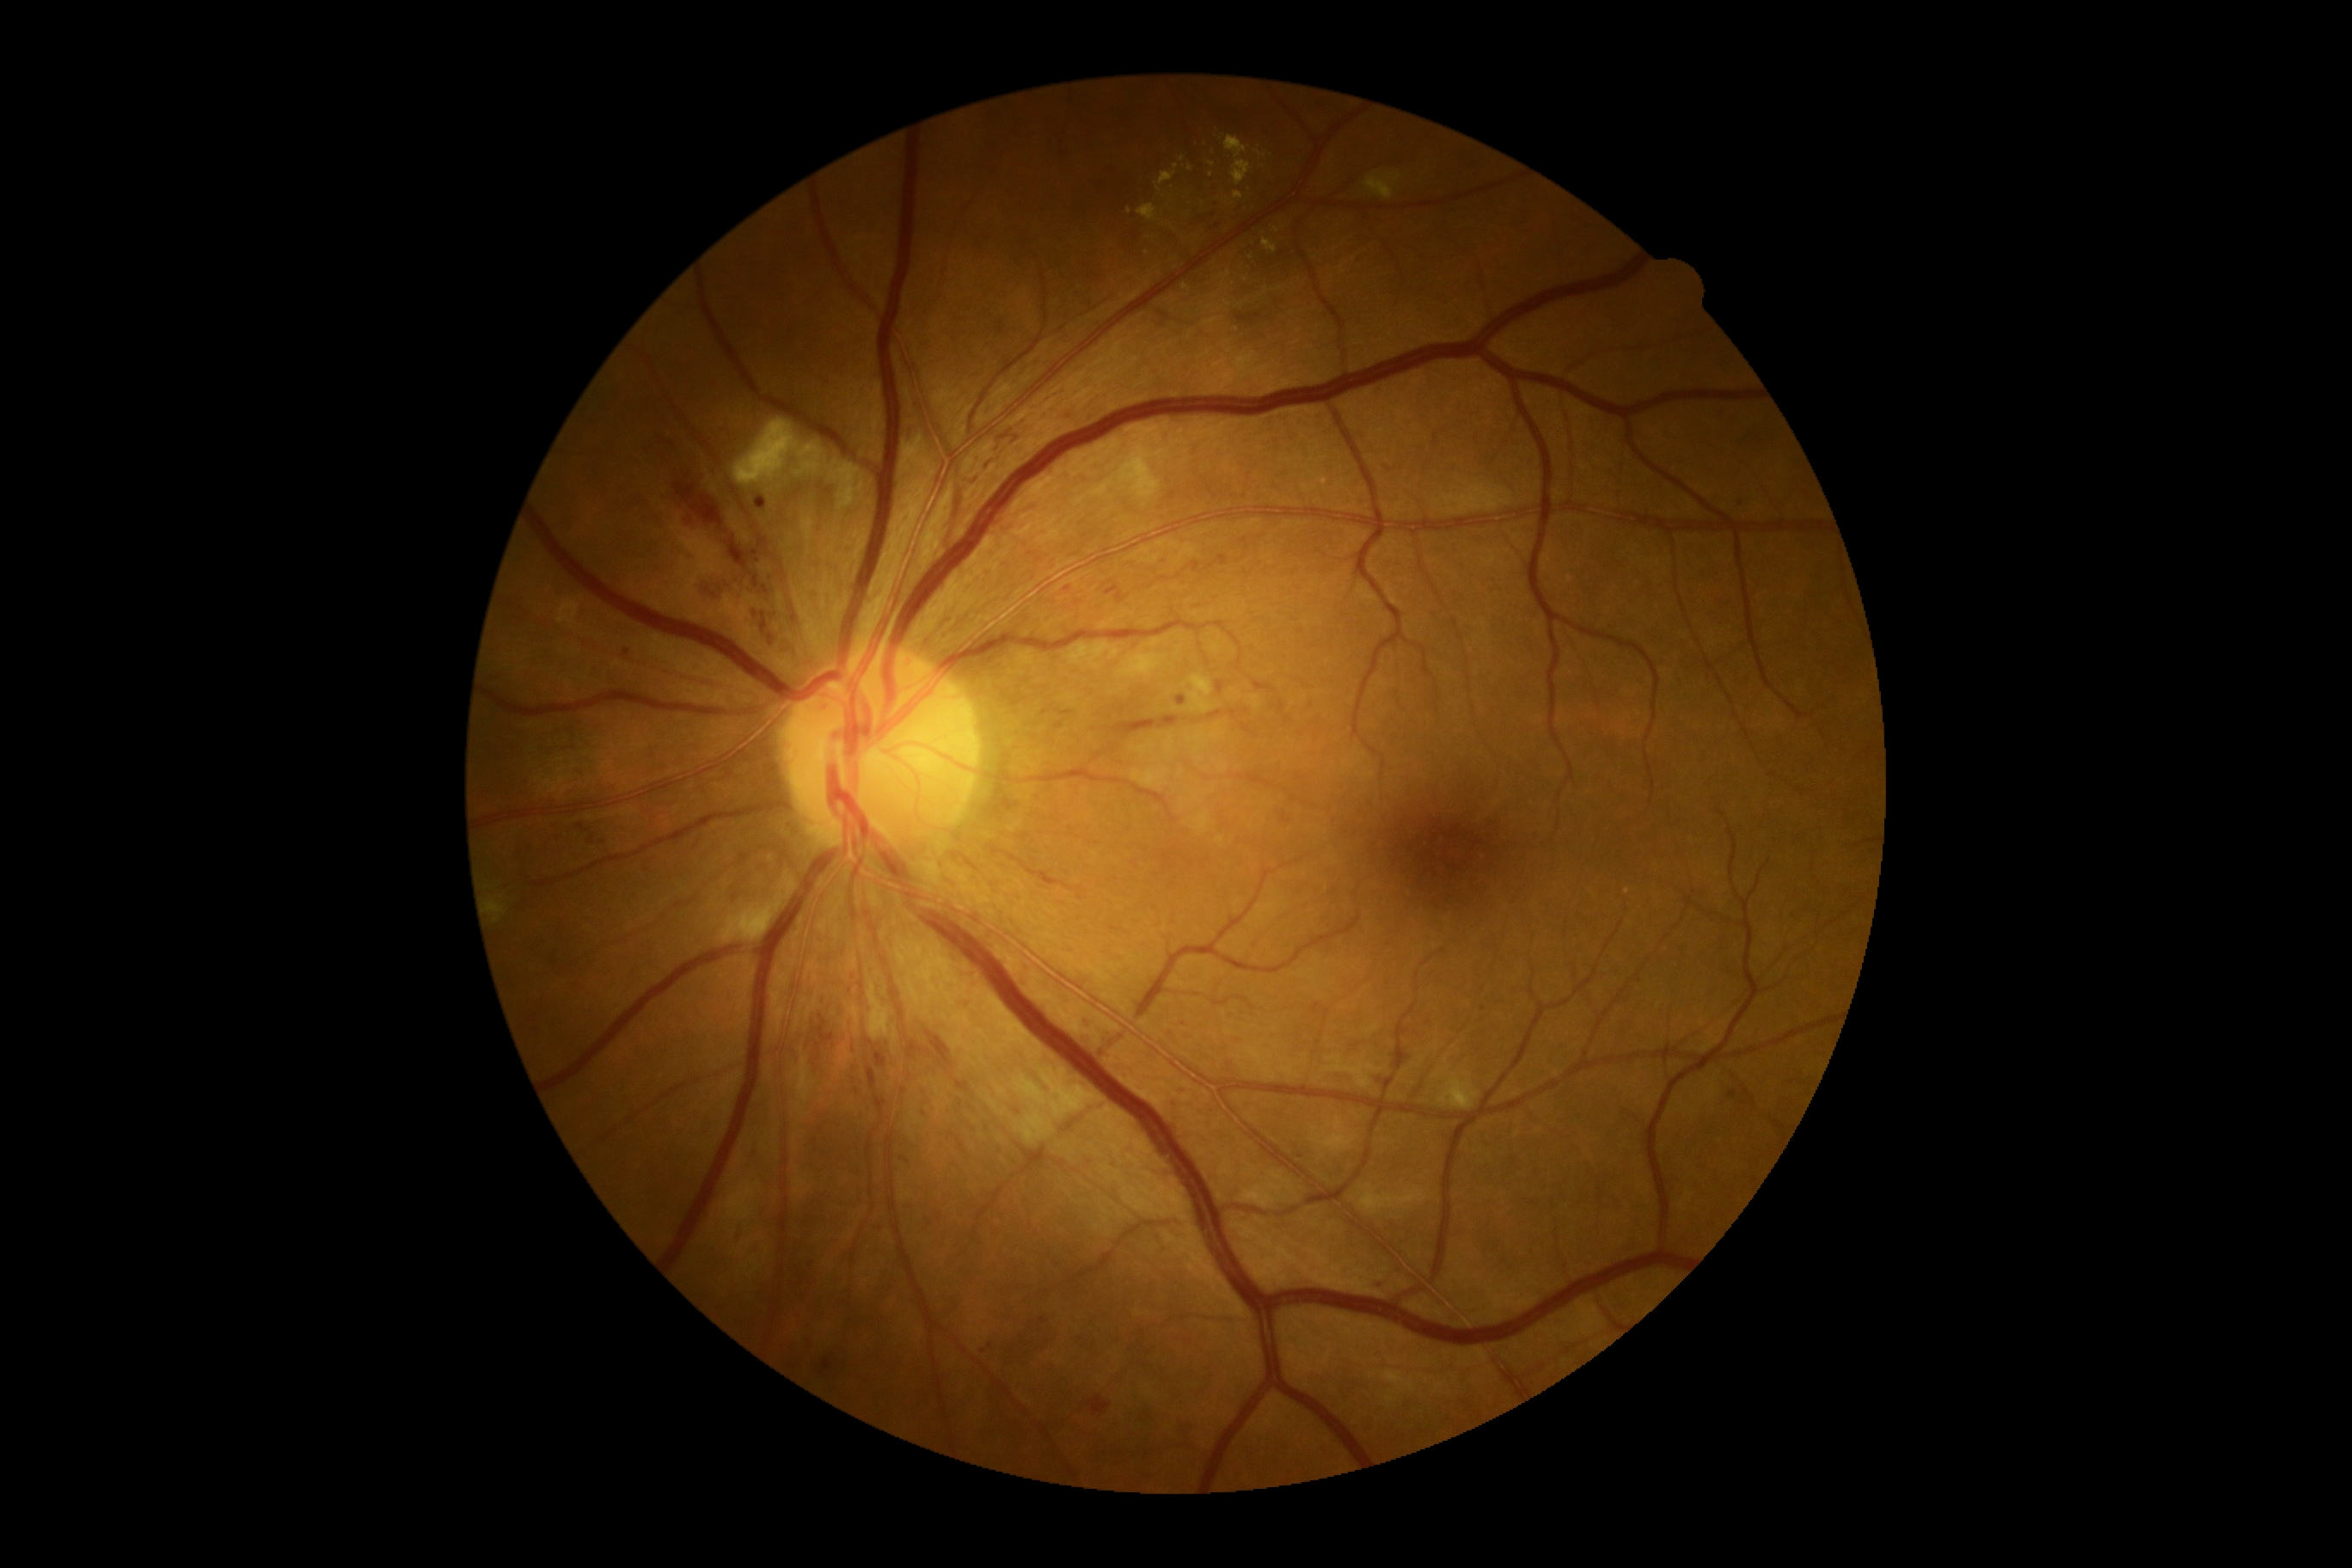 Retinopathy: moderate NPDR (grade 2).